CFP — 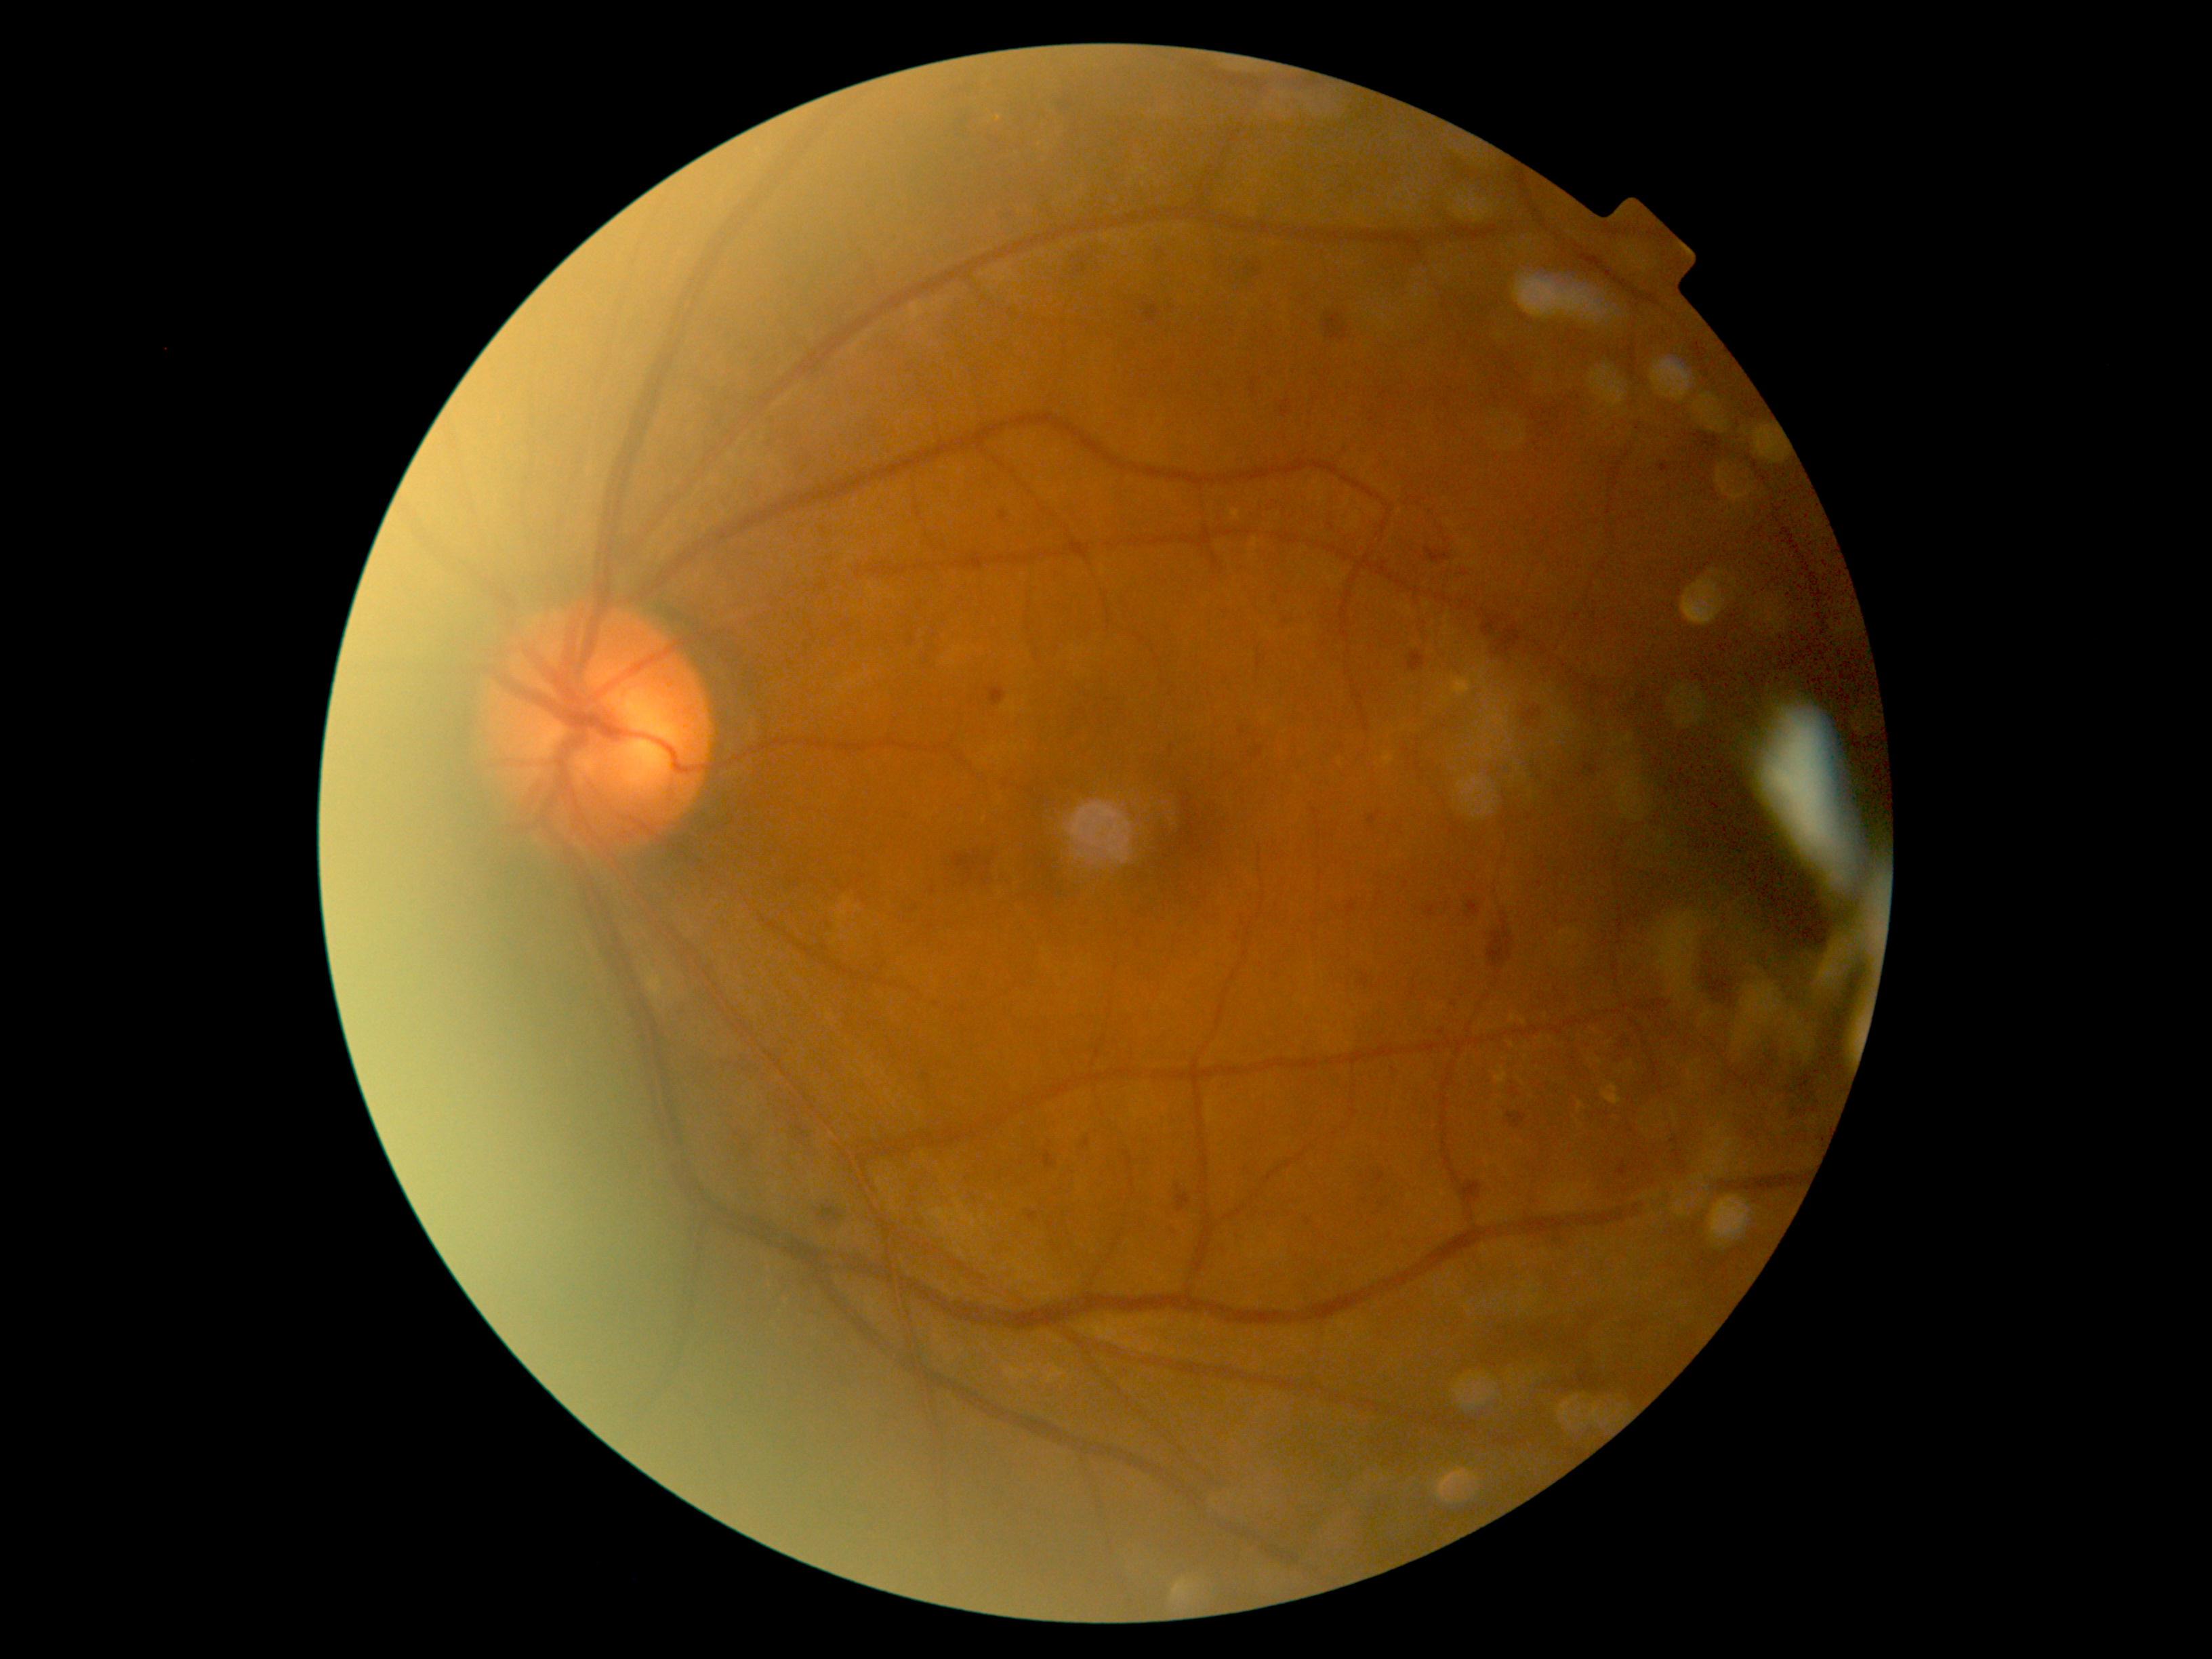

Diabetic retinopathy (DR): moderate non-proliferative diabetic retinopathy (grade 2).